848 by 848 pixels; 45-degree field of view: 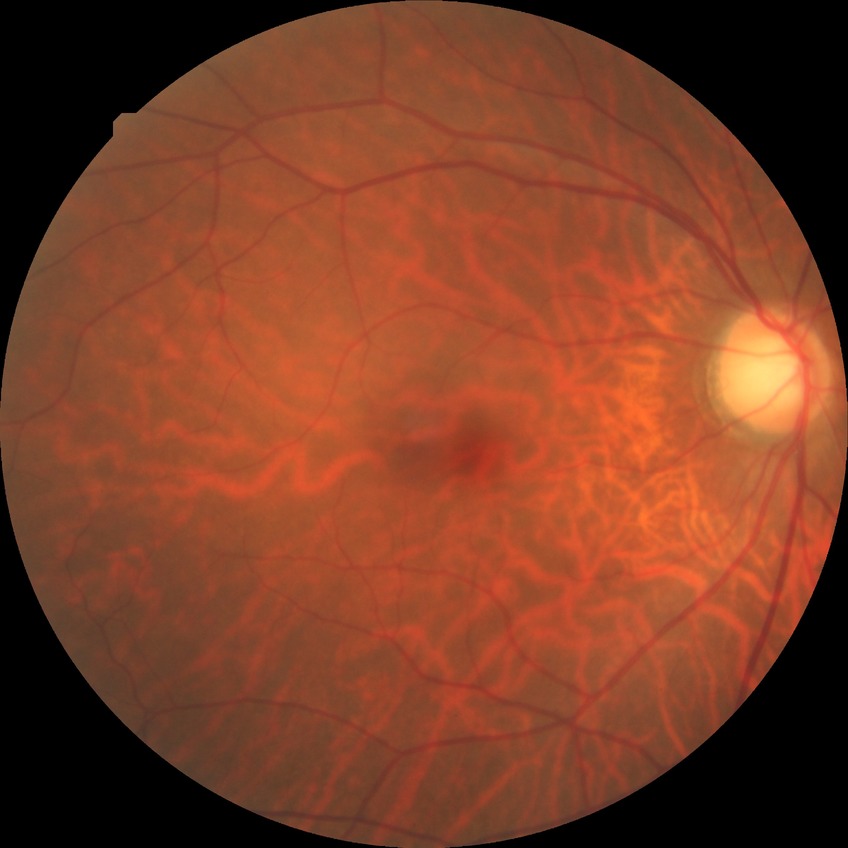
Diabetic retinopathy stage: no diabetic retinopathy.